Pediatric wide-field fundus photograph. 640x480. Acquired on the Clarity RetCam 3: 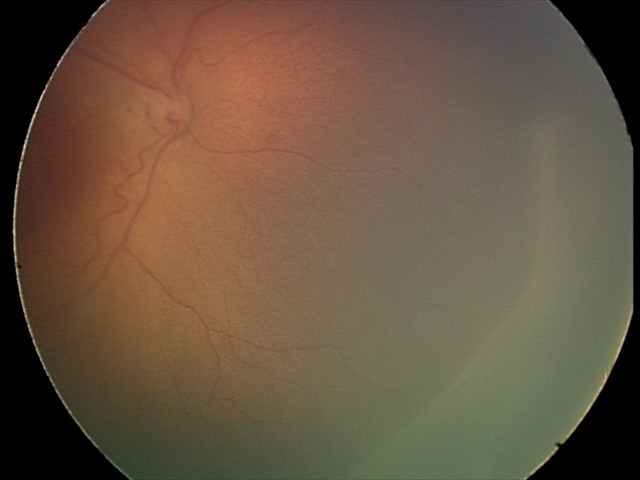
Examination diagnosed as retinopathy of prematurity (ROP) stage 2. Plus disease absent.